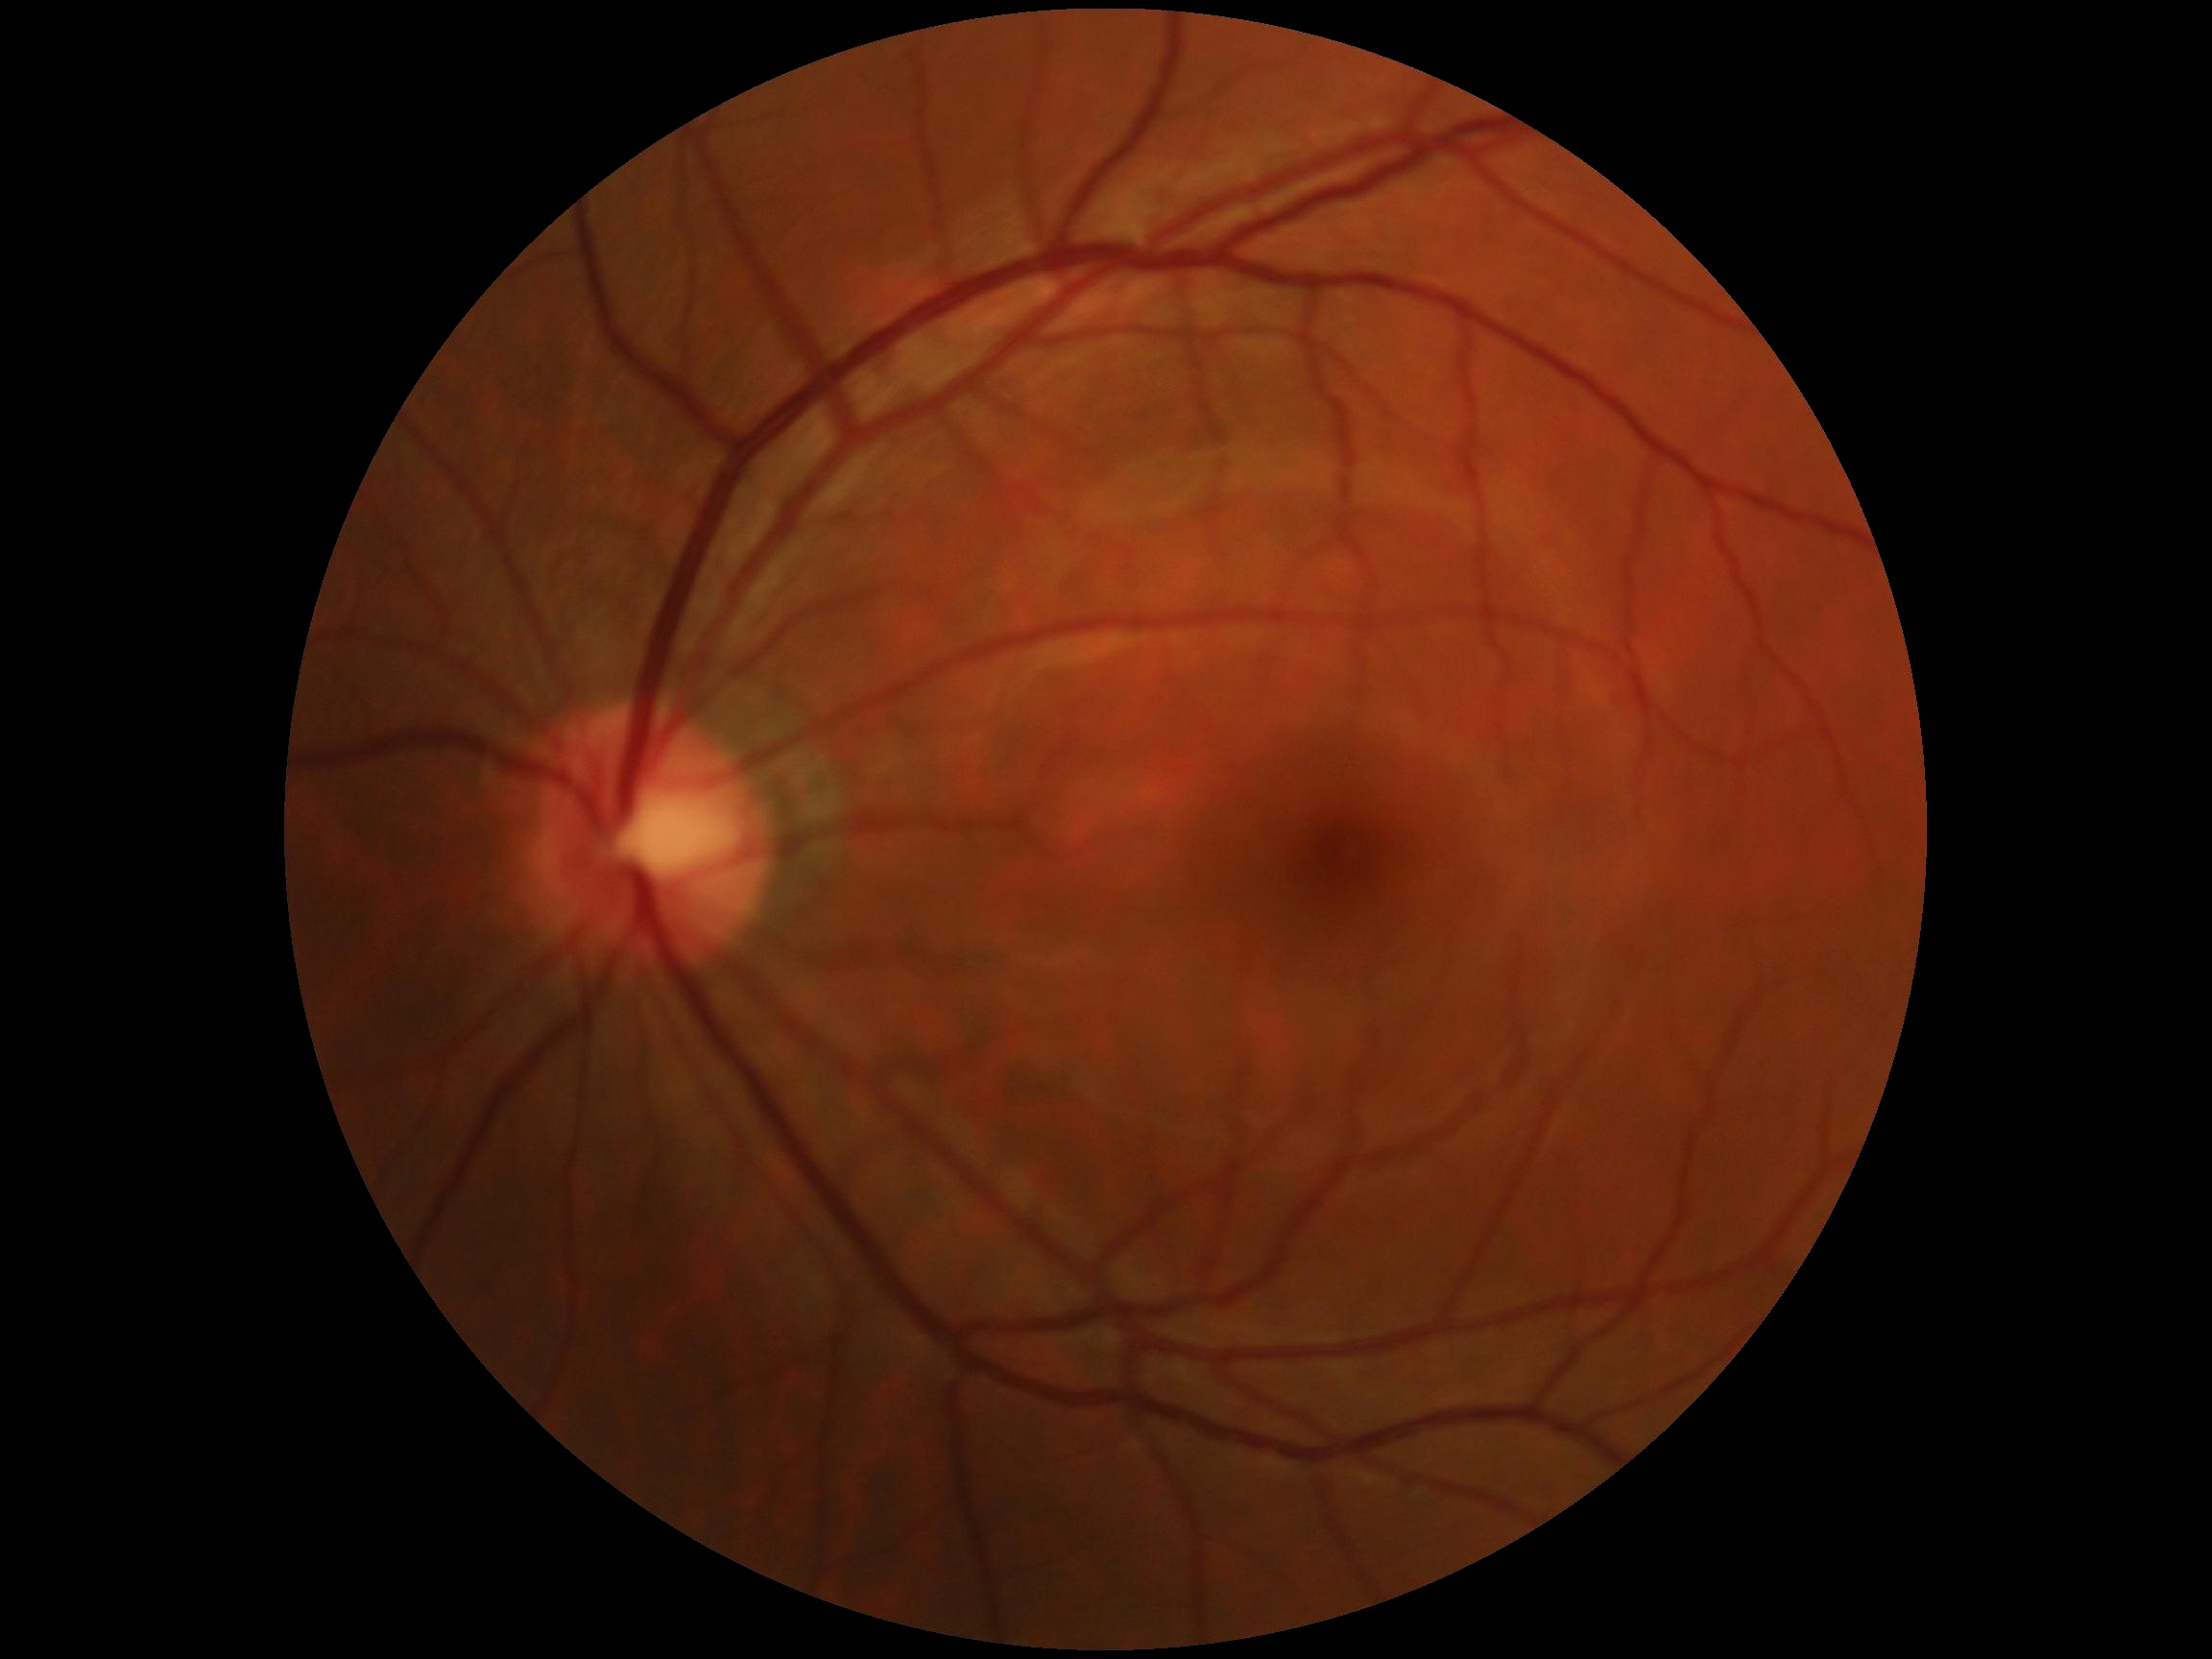

Diabetic retinopathy grade: 0 (no apparent retinopathy) — no visible signs of diabetic retinopathy.